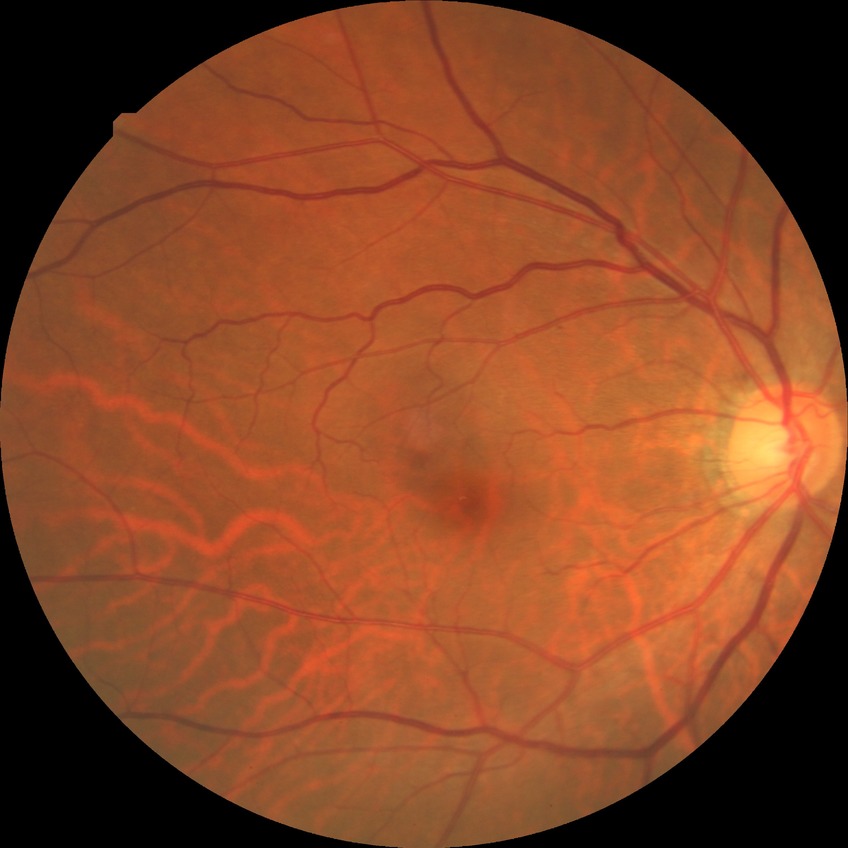
Annotations:
• diabetic retinopathy (DR) — NDR (no diabetic retinopathy)